Modified Davis classification.
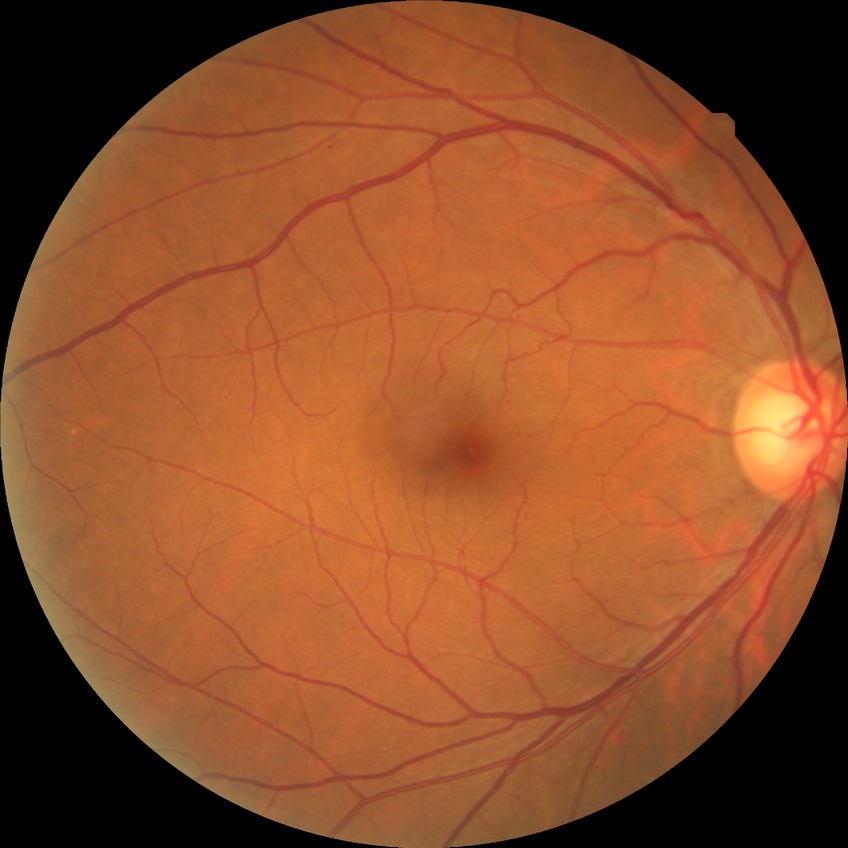
  davis_grade: SDR (simple diabetic retinopathy)